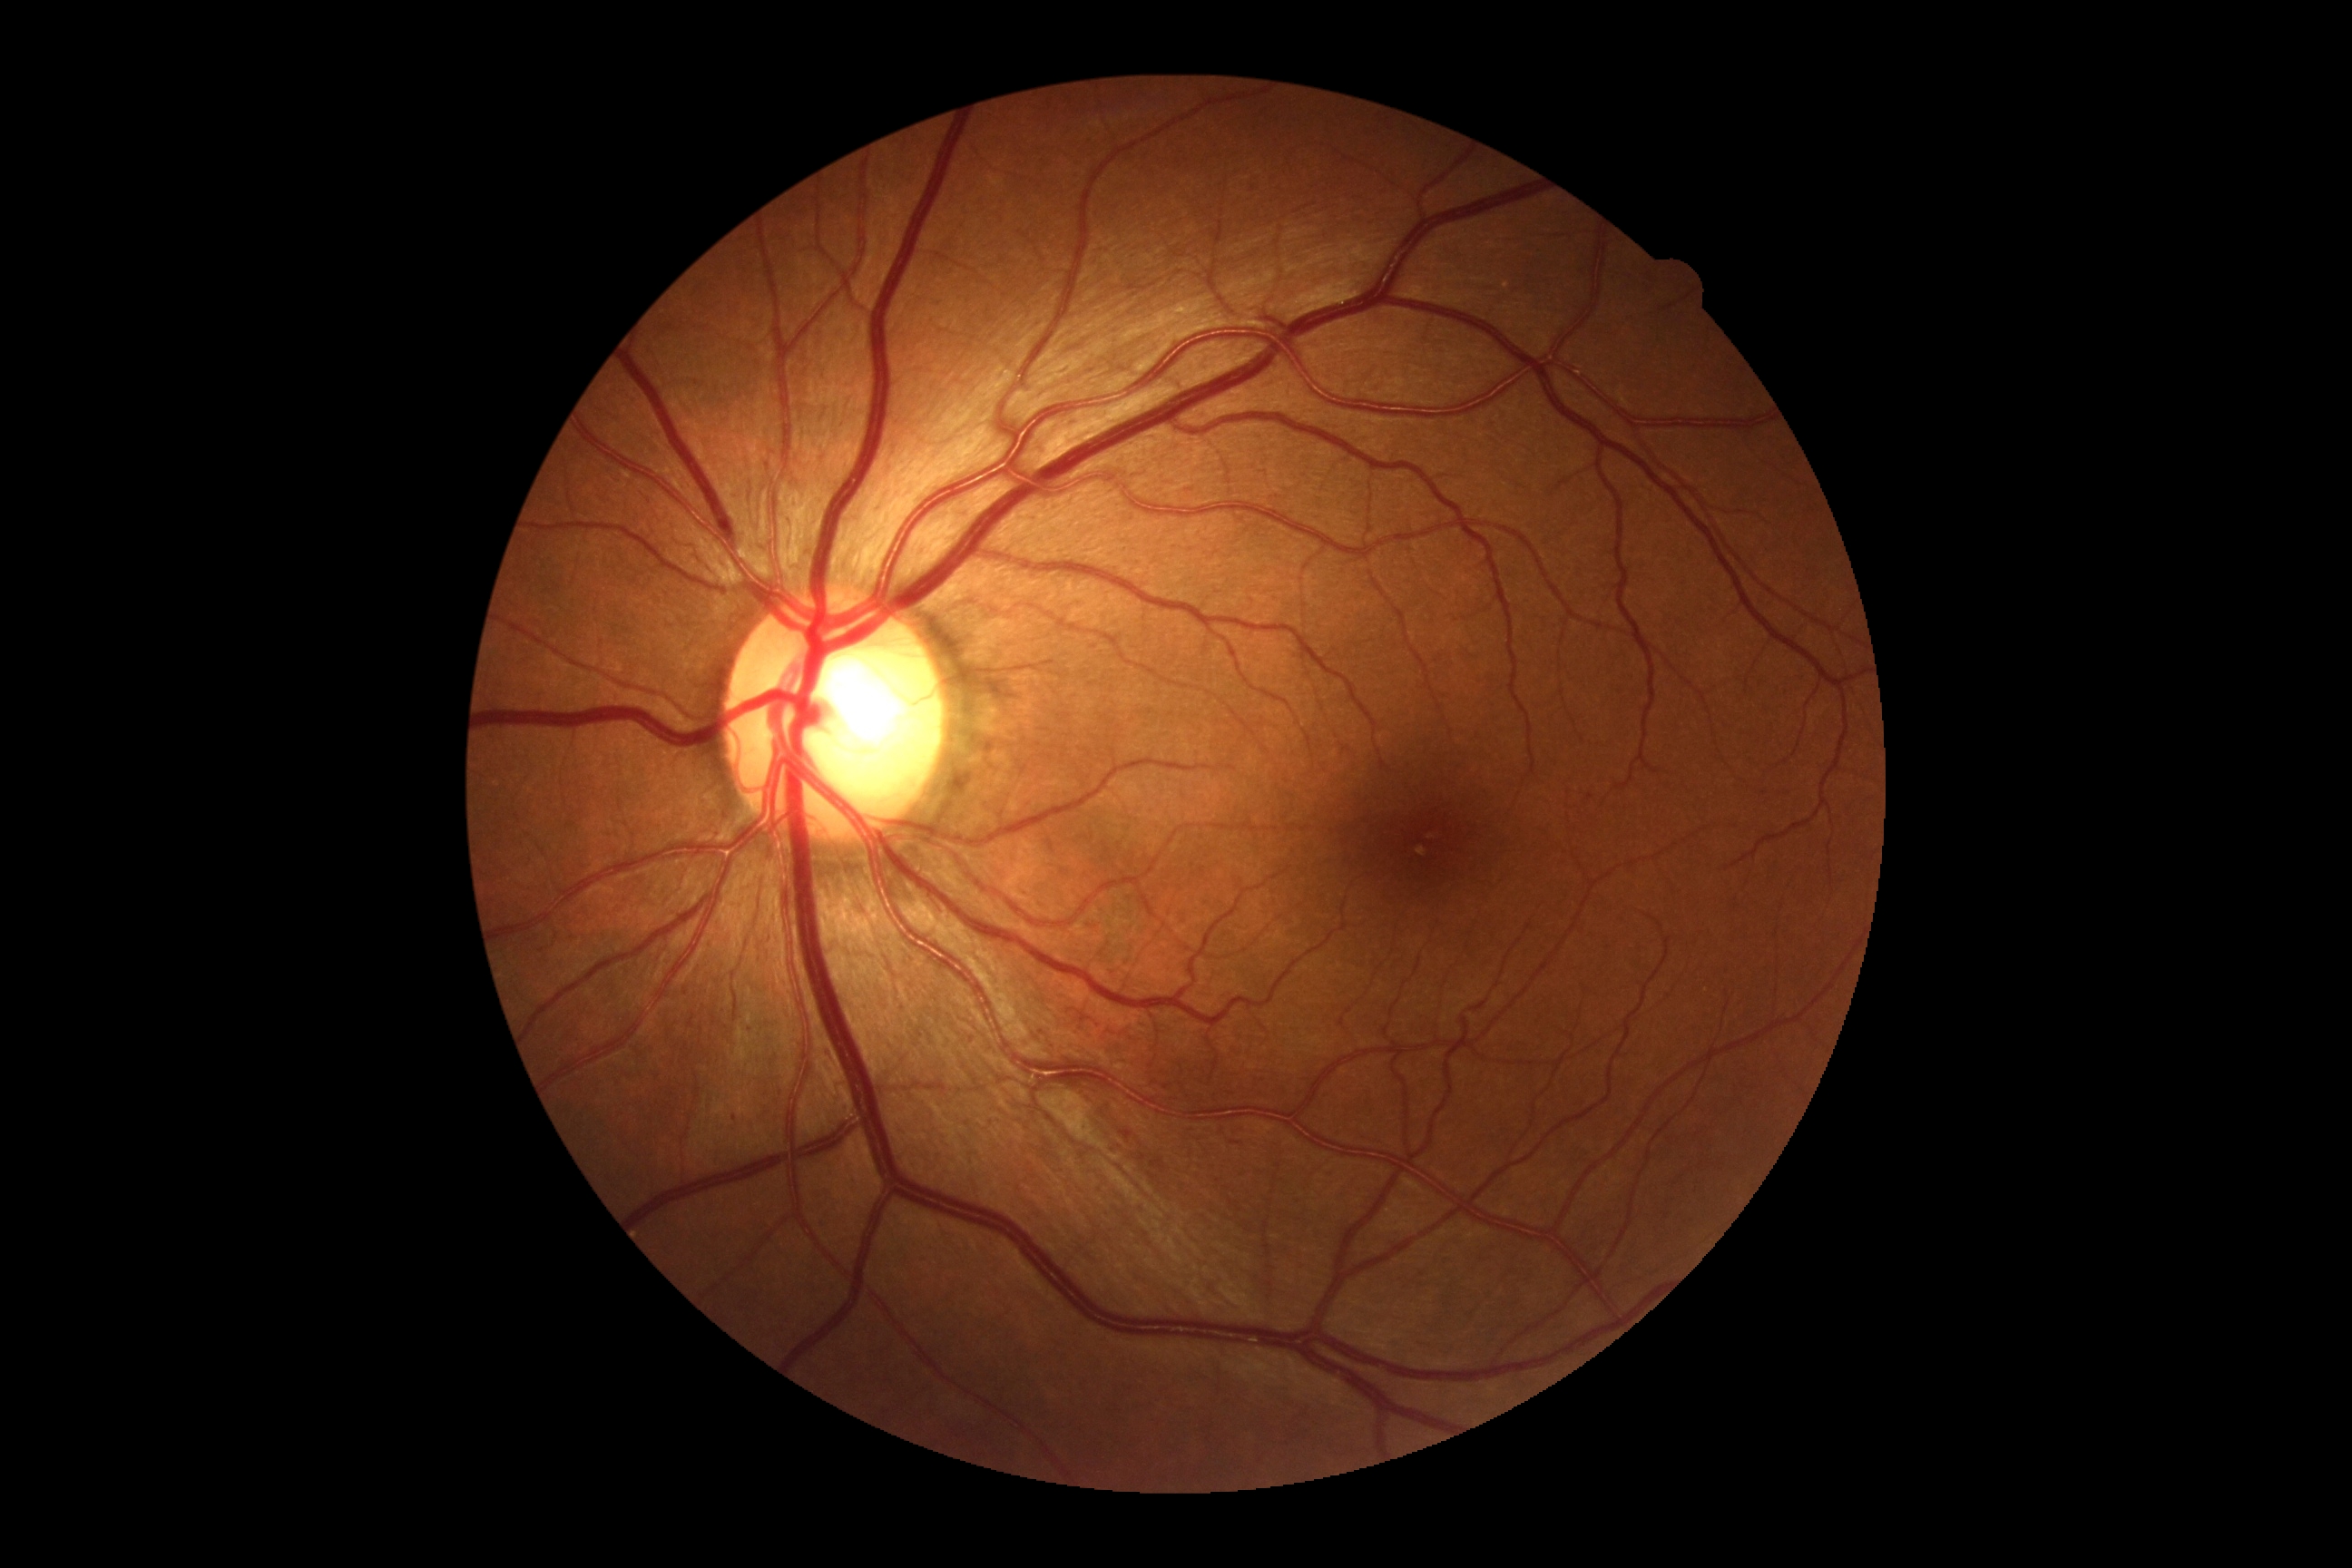

- DR — grade 1 (mild NPDR)